2352x1568px, 45° FOV, fundus photo: 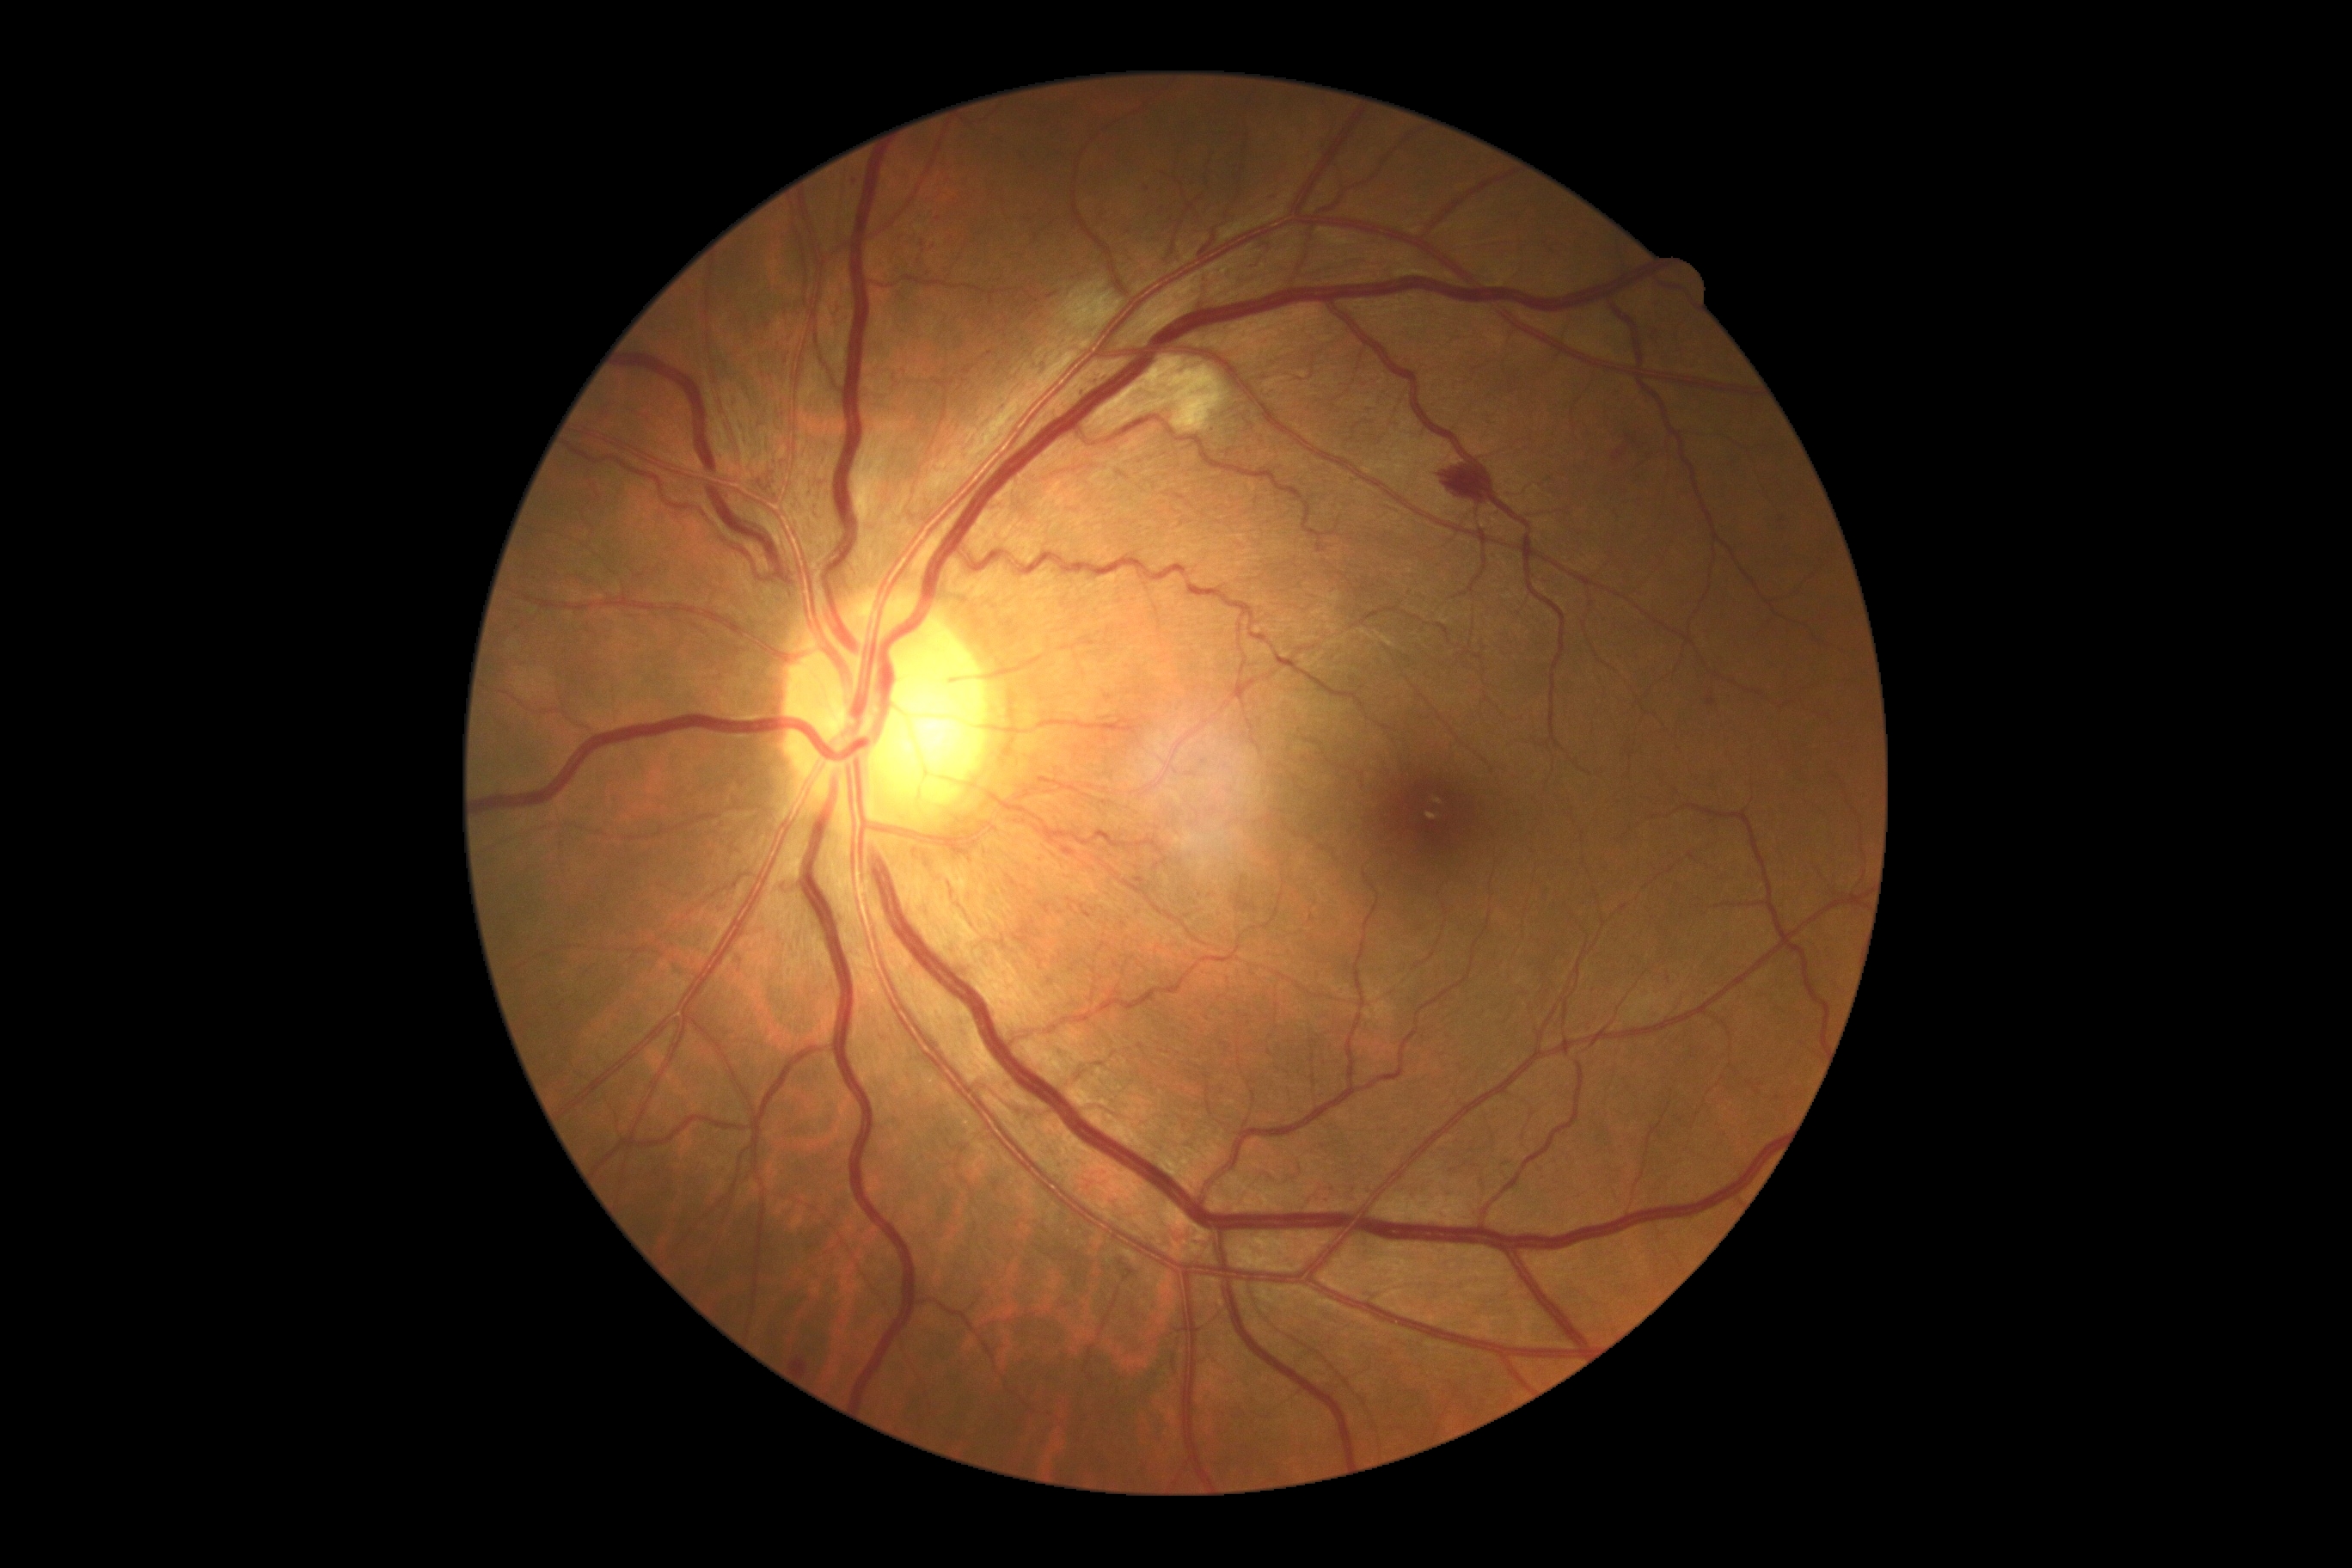
DR grade is 3.